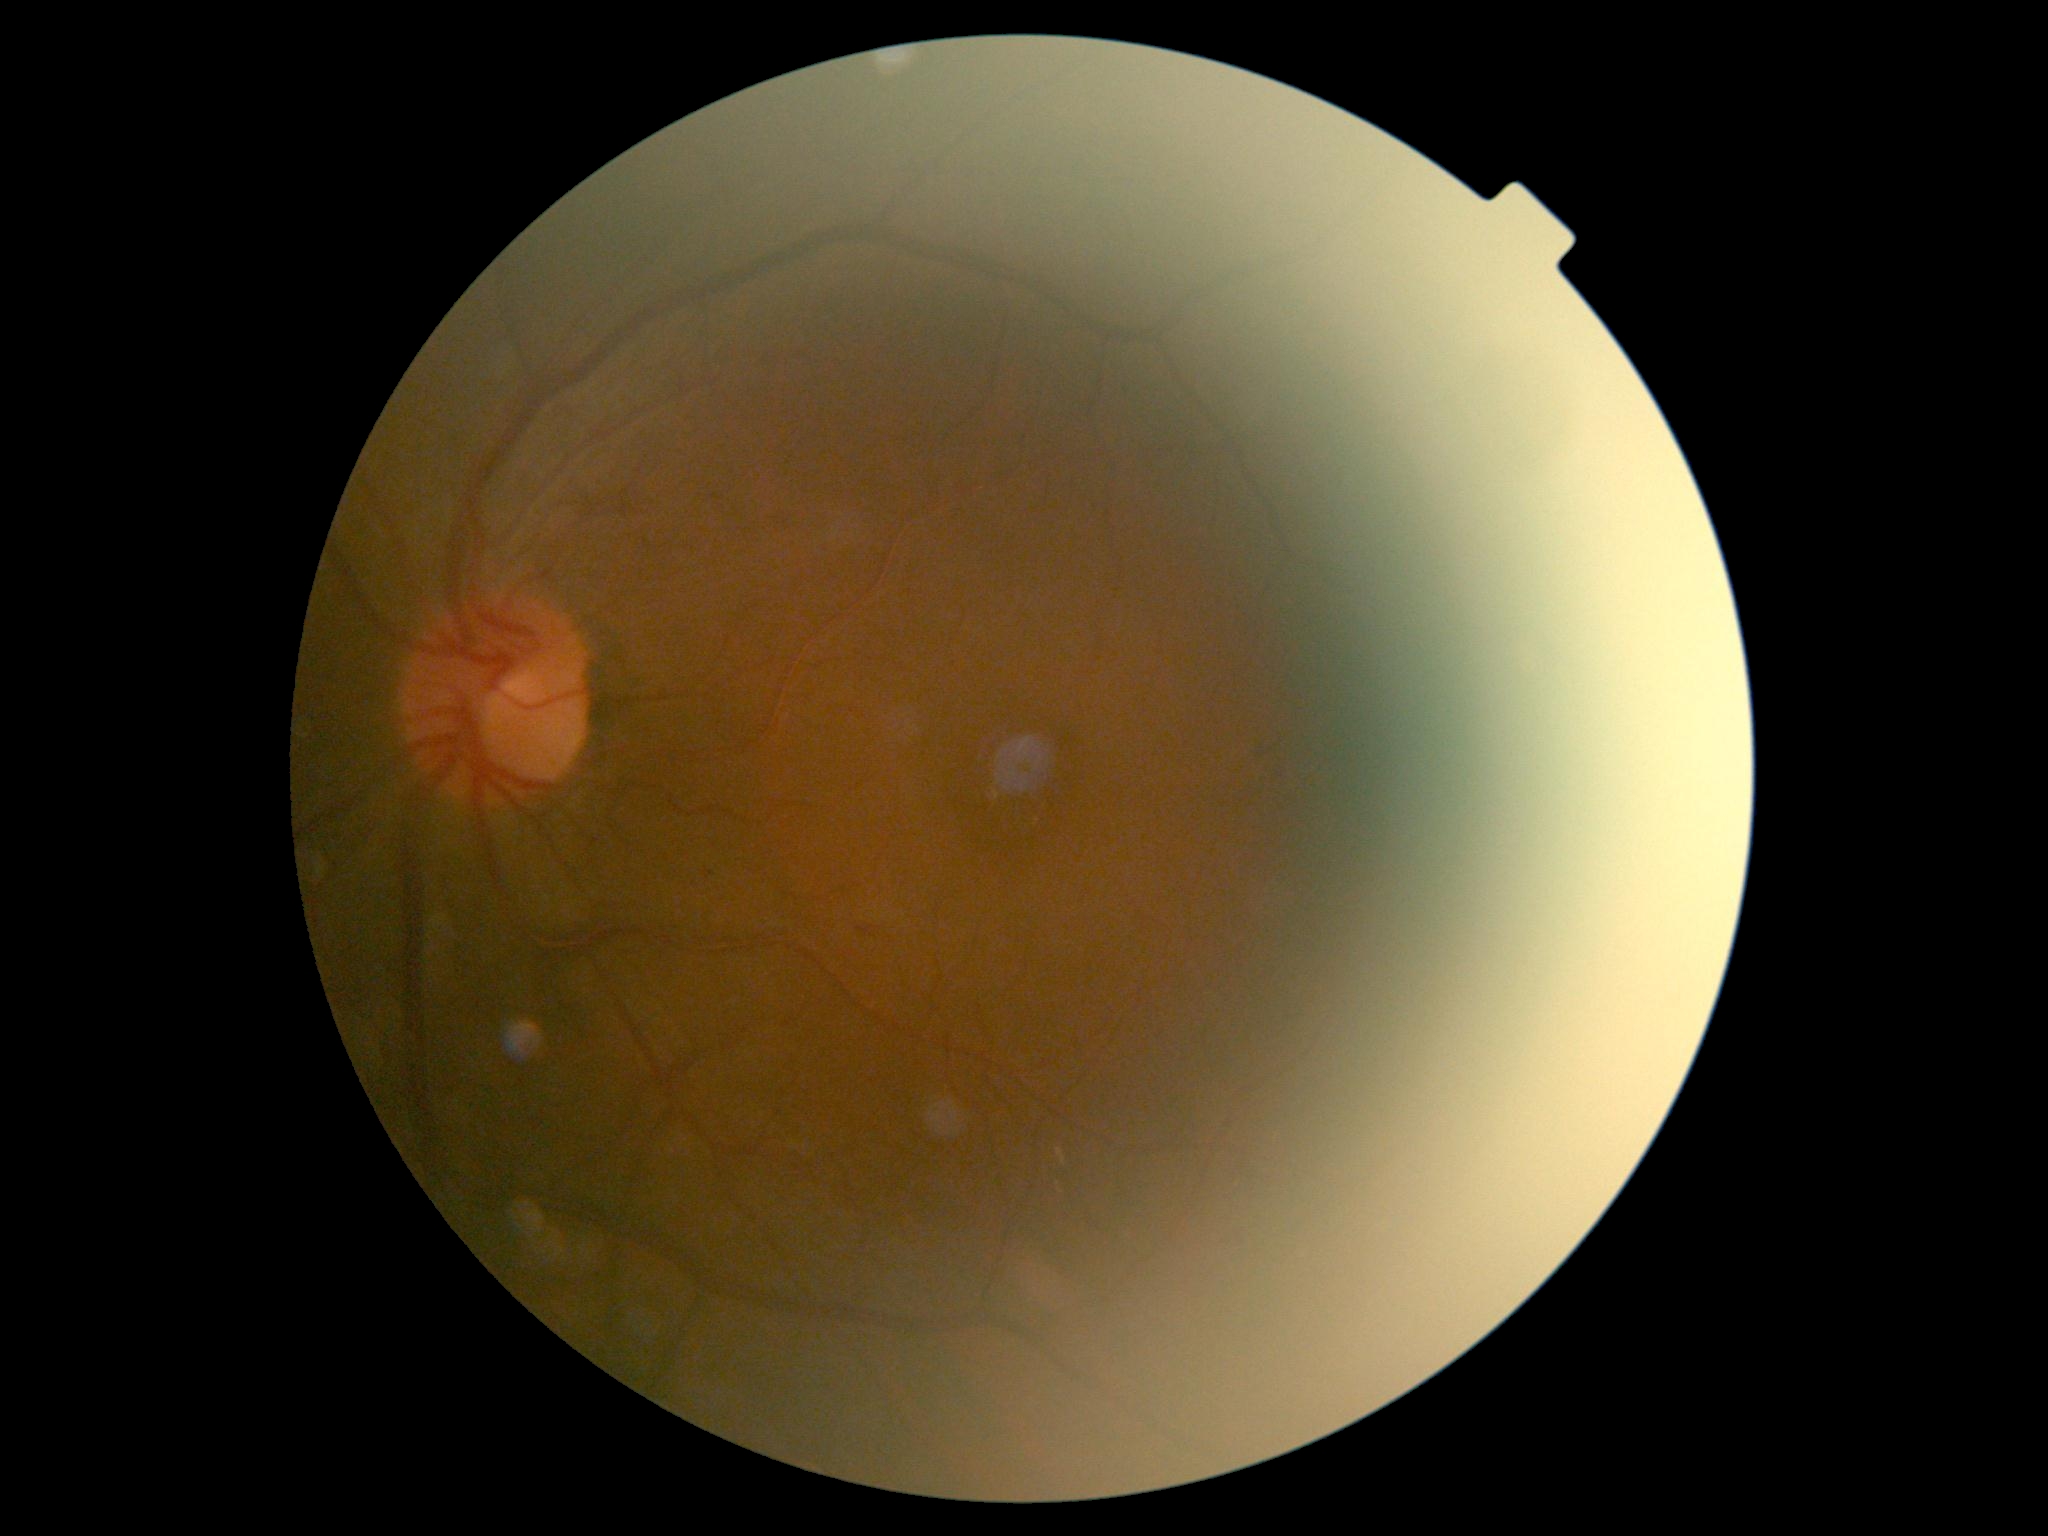
DR class: non-proliferative diabetic retinopathy.
DR stage: 2.